Image size 1440x1080. Pediatric retinal photograph (wide-field) — 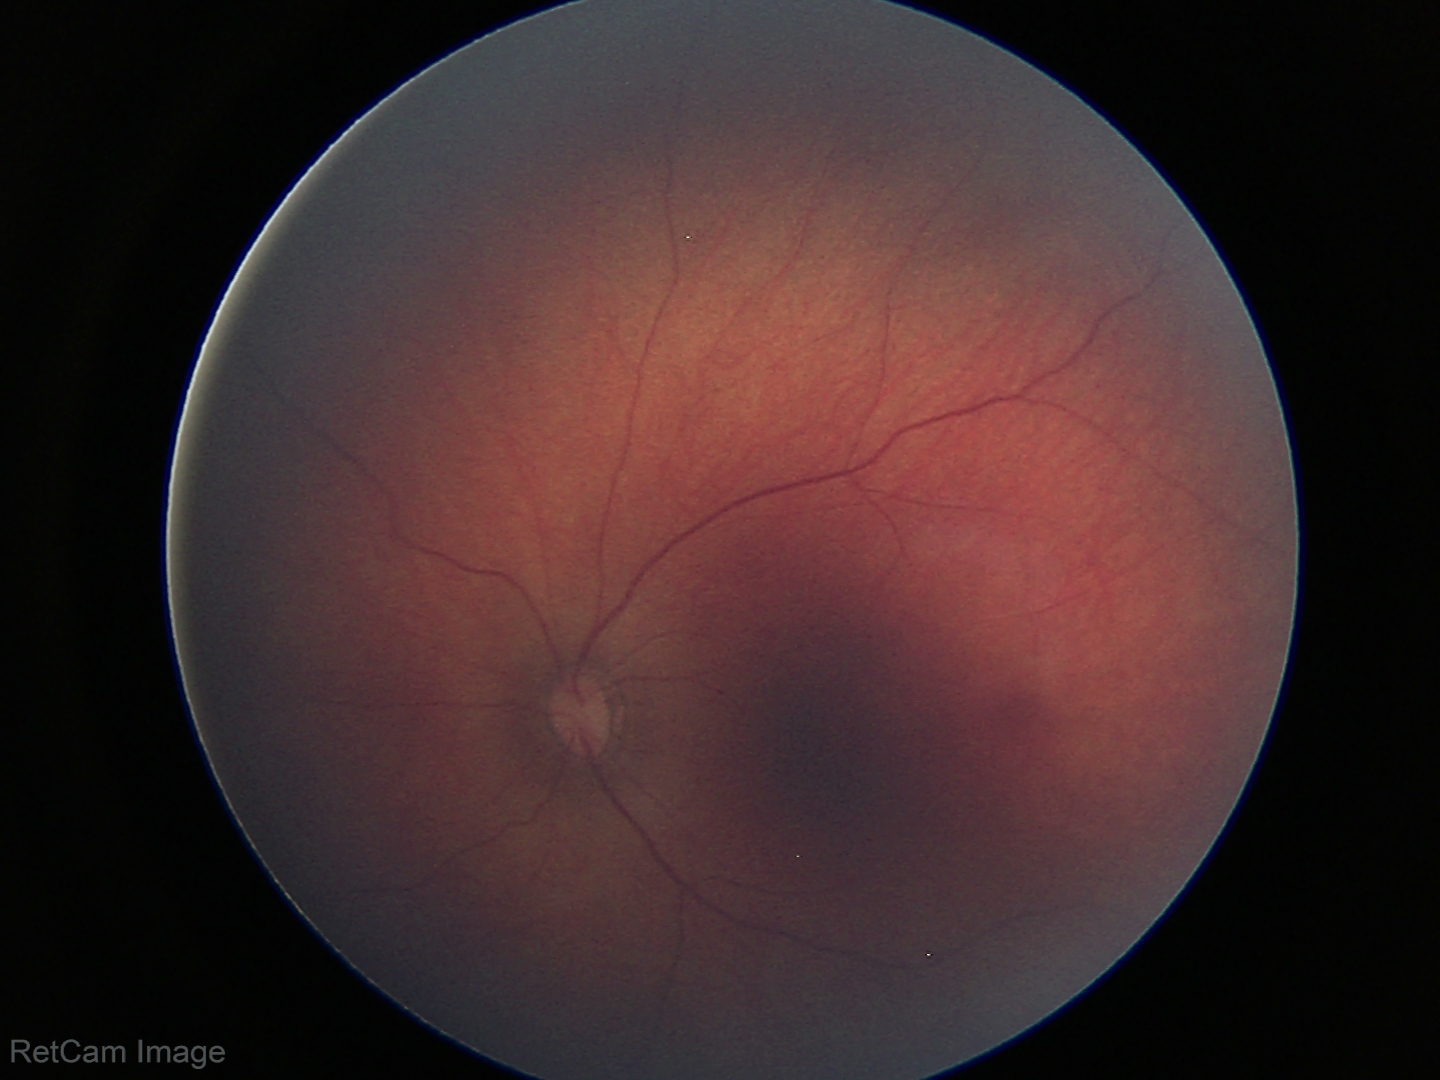

Q: What was the screening finding?
A: normal fundus examination